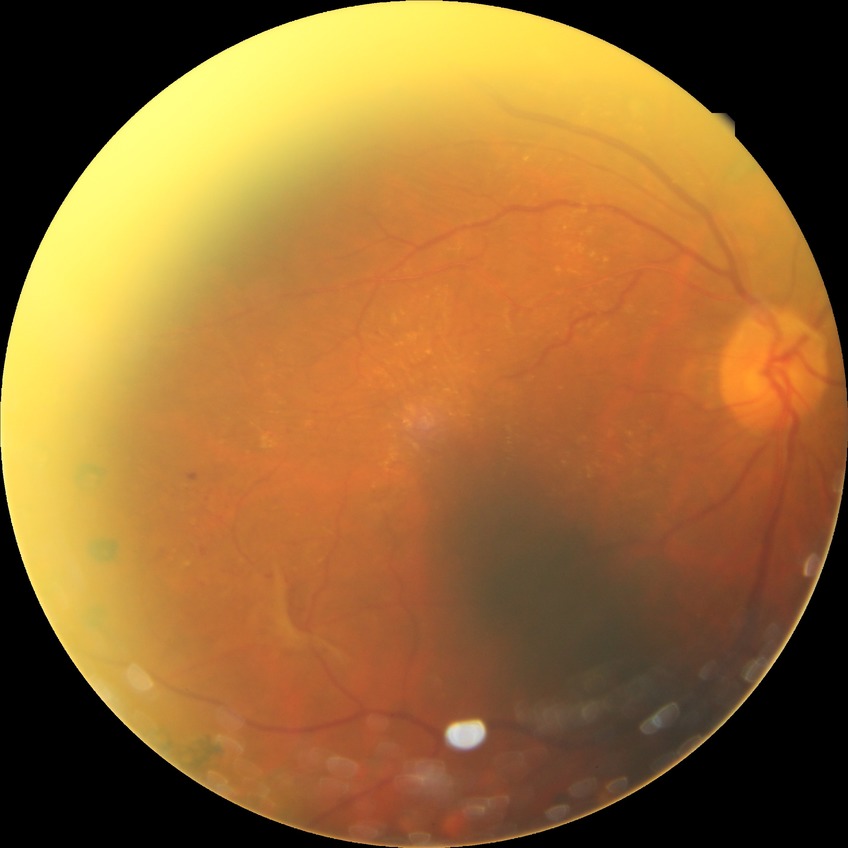

Retinopathy grade is proliferative diabetic retinopathy.